Acquired with a Topcon TRC-50DX
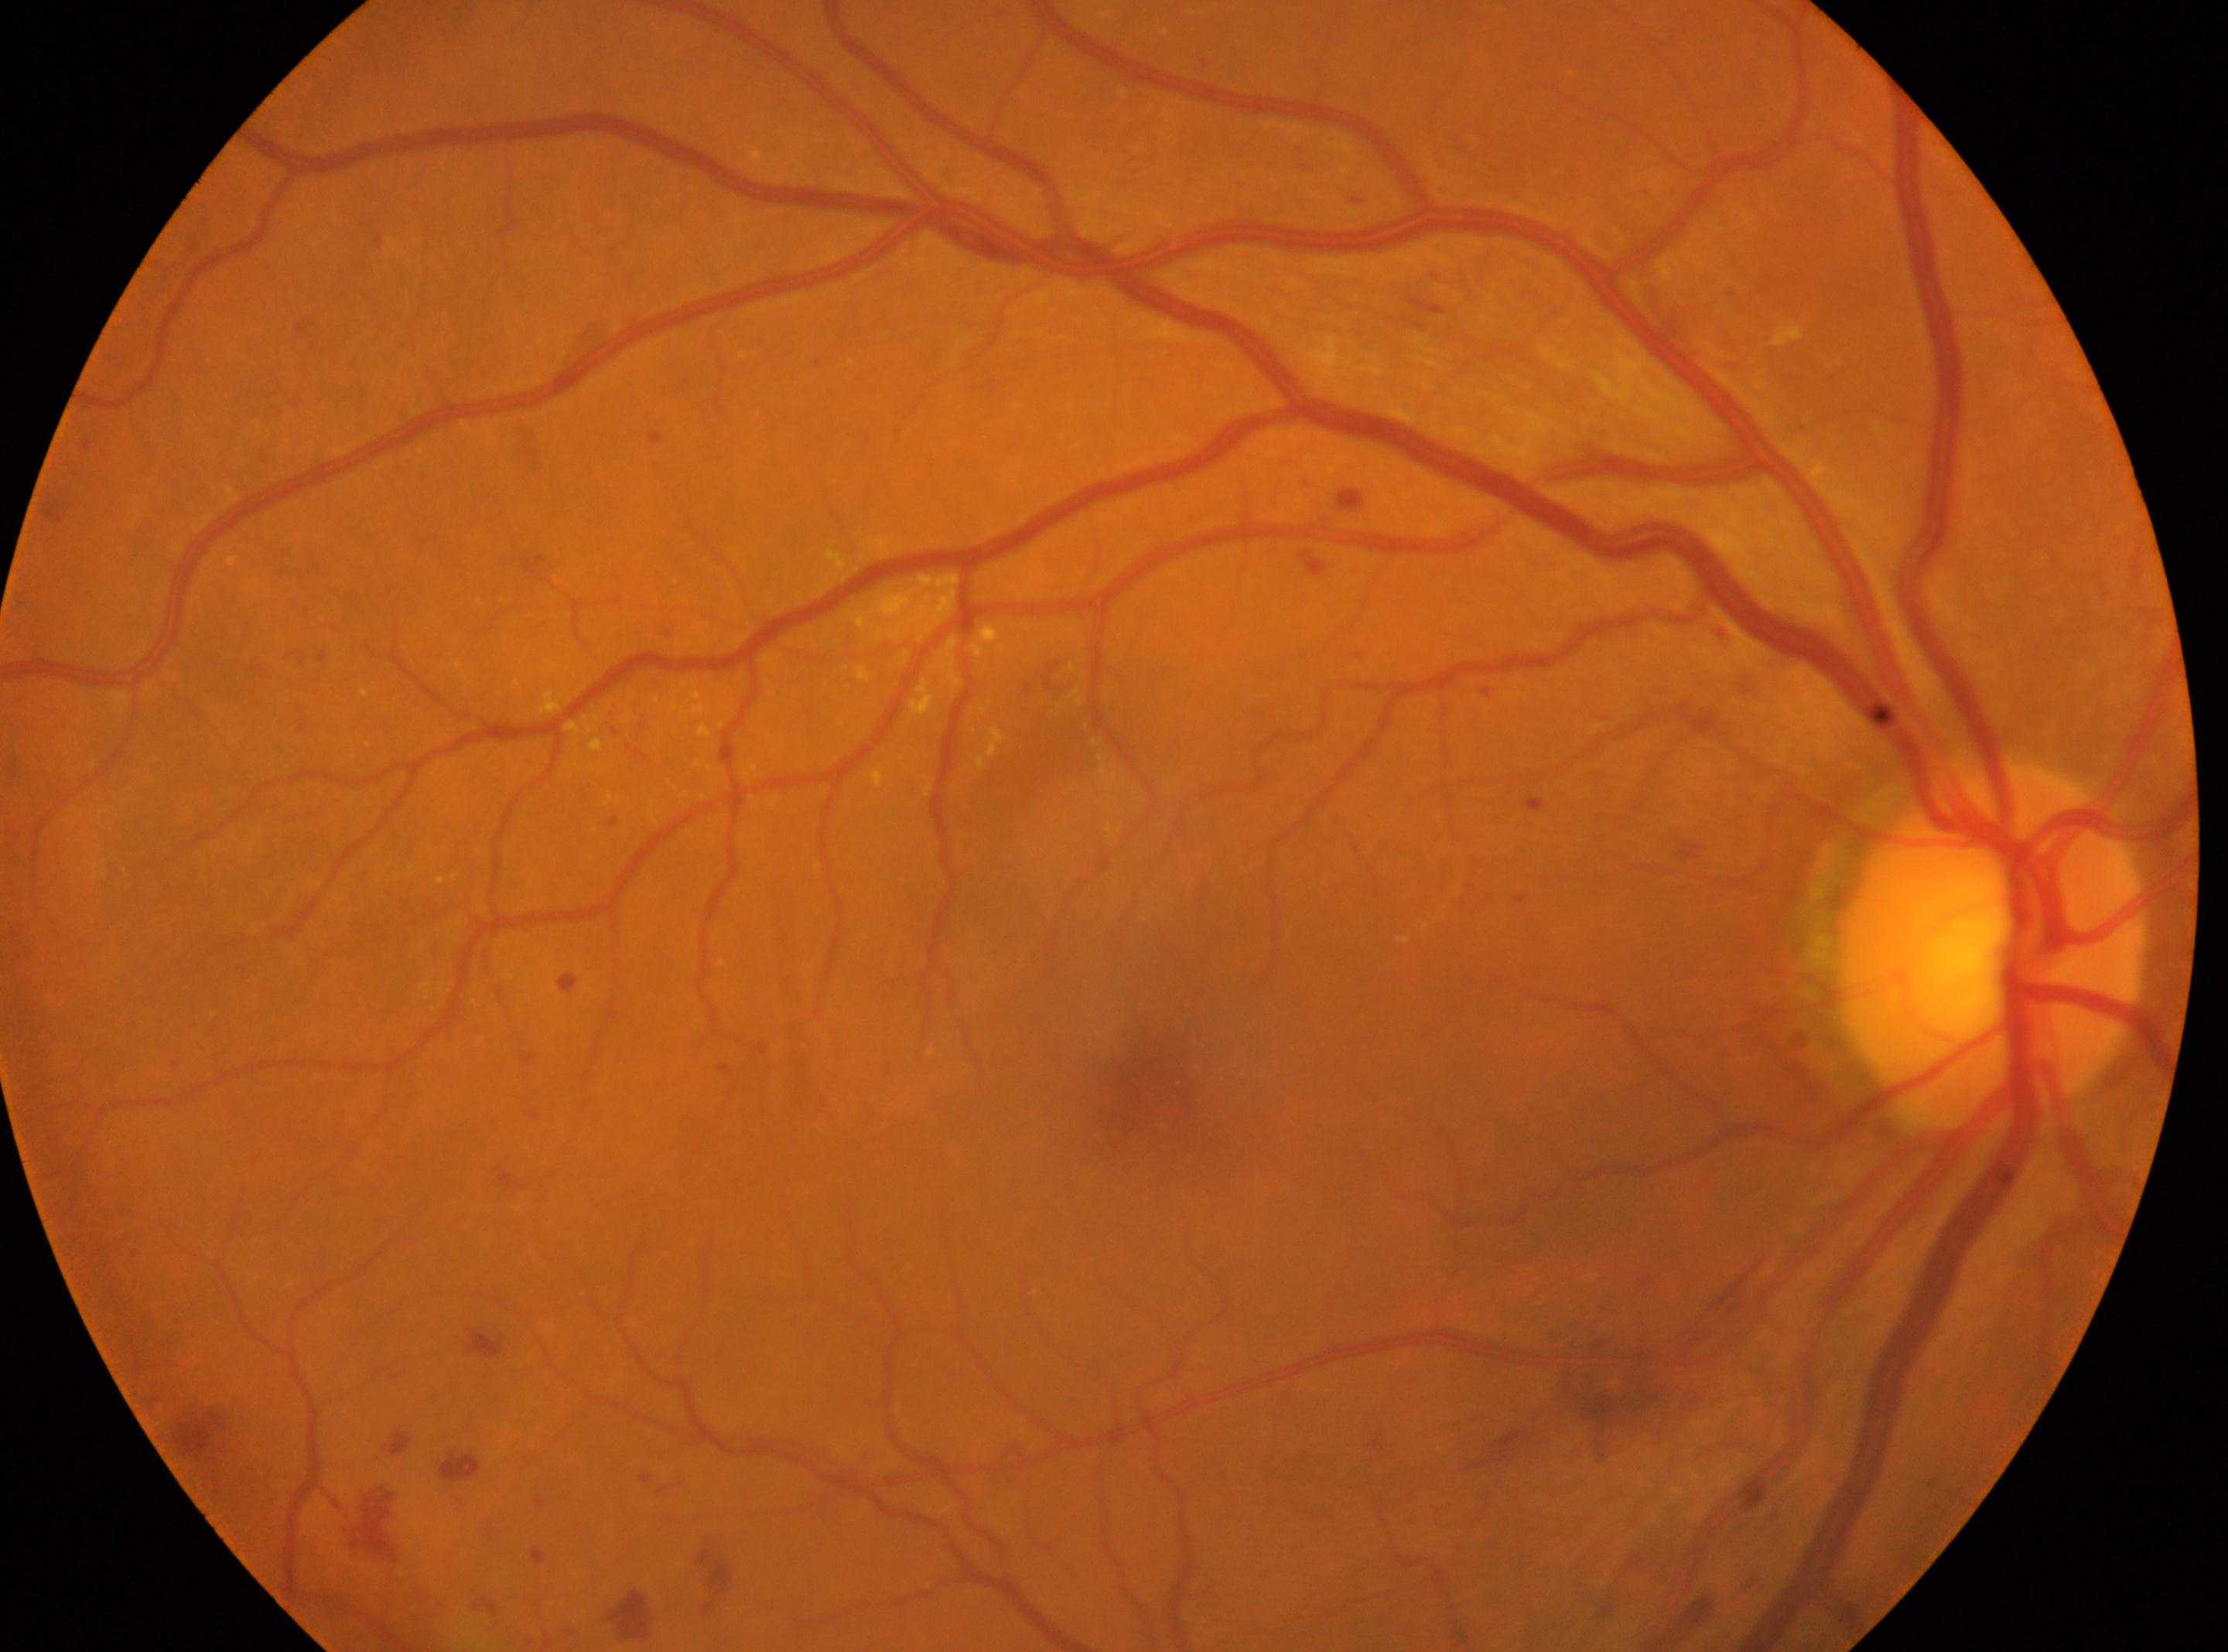

Diabetic retinopathy: moderate NPDR (grade 2).
The optic disc is at (x: 1989, y: 947).
The image shows the right eye.
The macula center is at (x: 1146, y: 1084).